Pediatric wide-field fundus photograph: 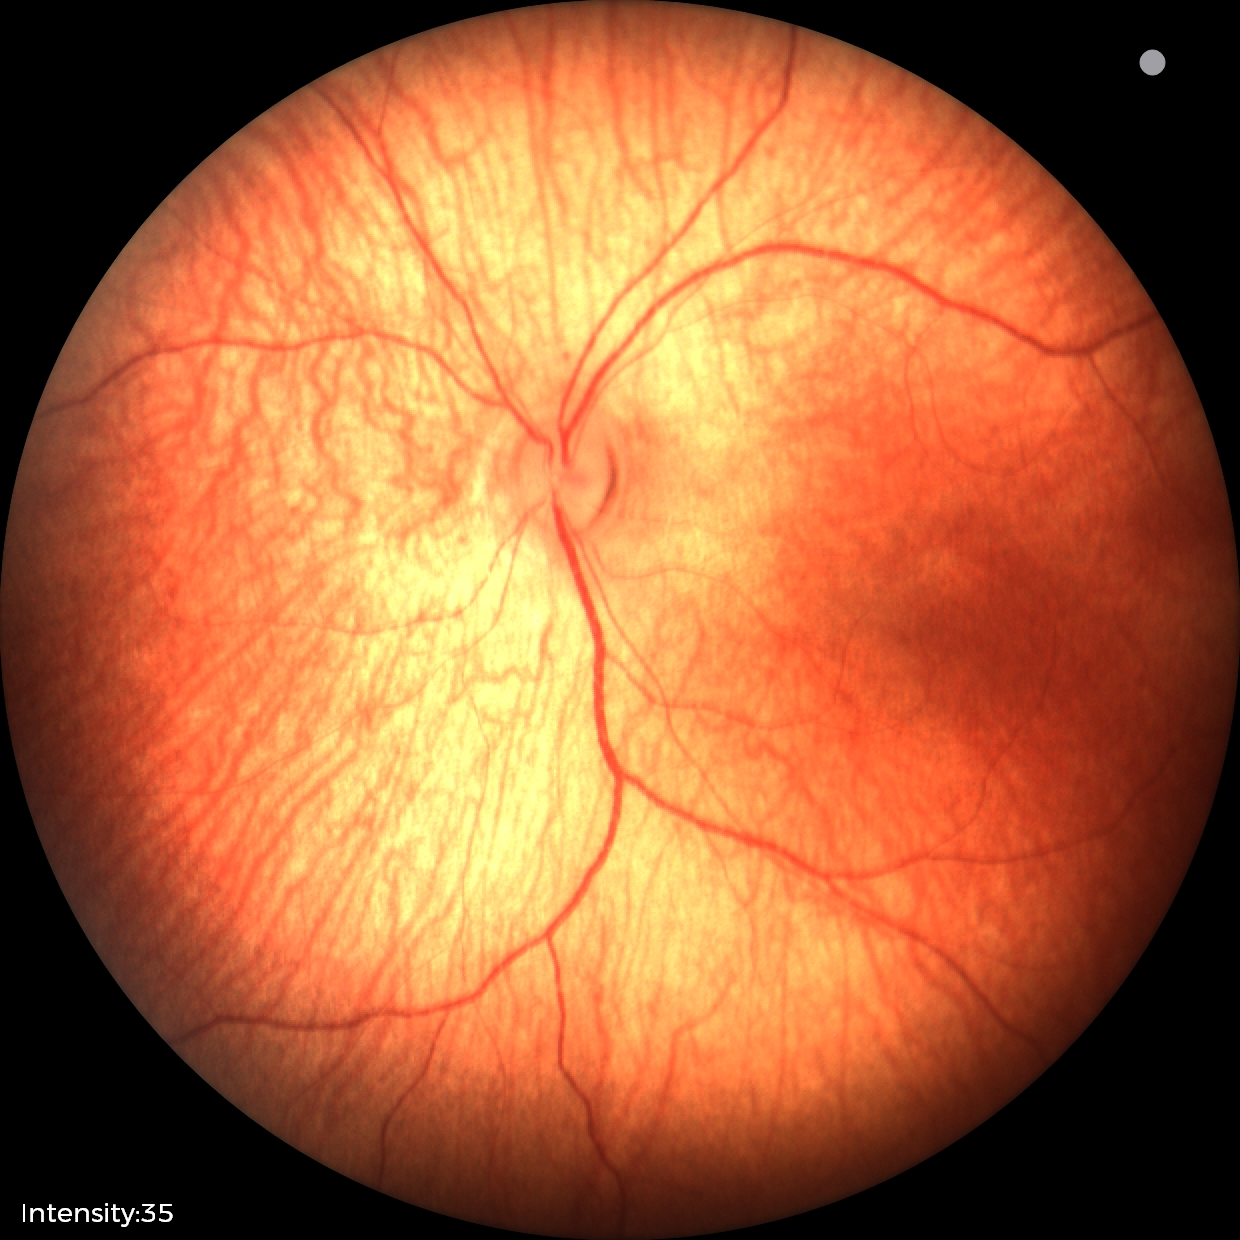
No retinal pathology identified on screening.